Retinal fundus photograph, 45-degree field of view — 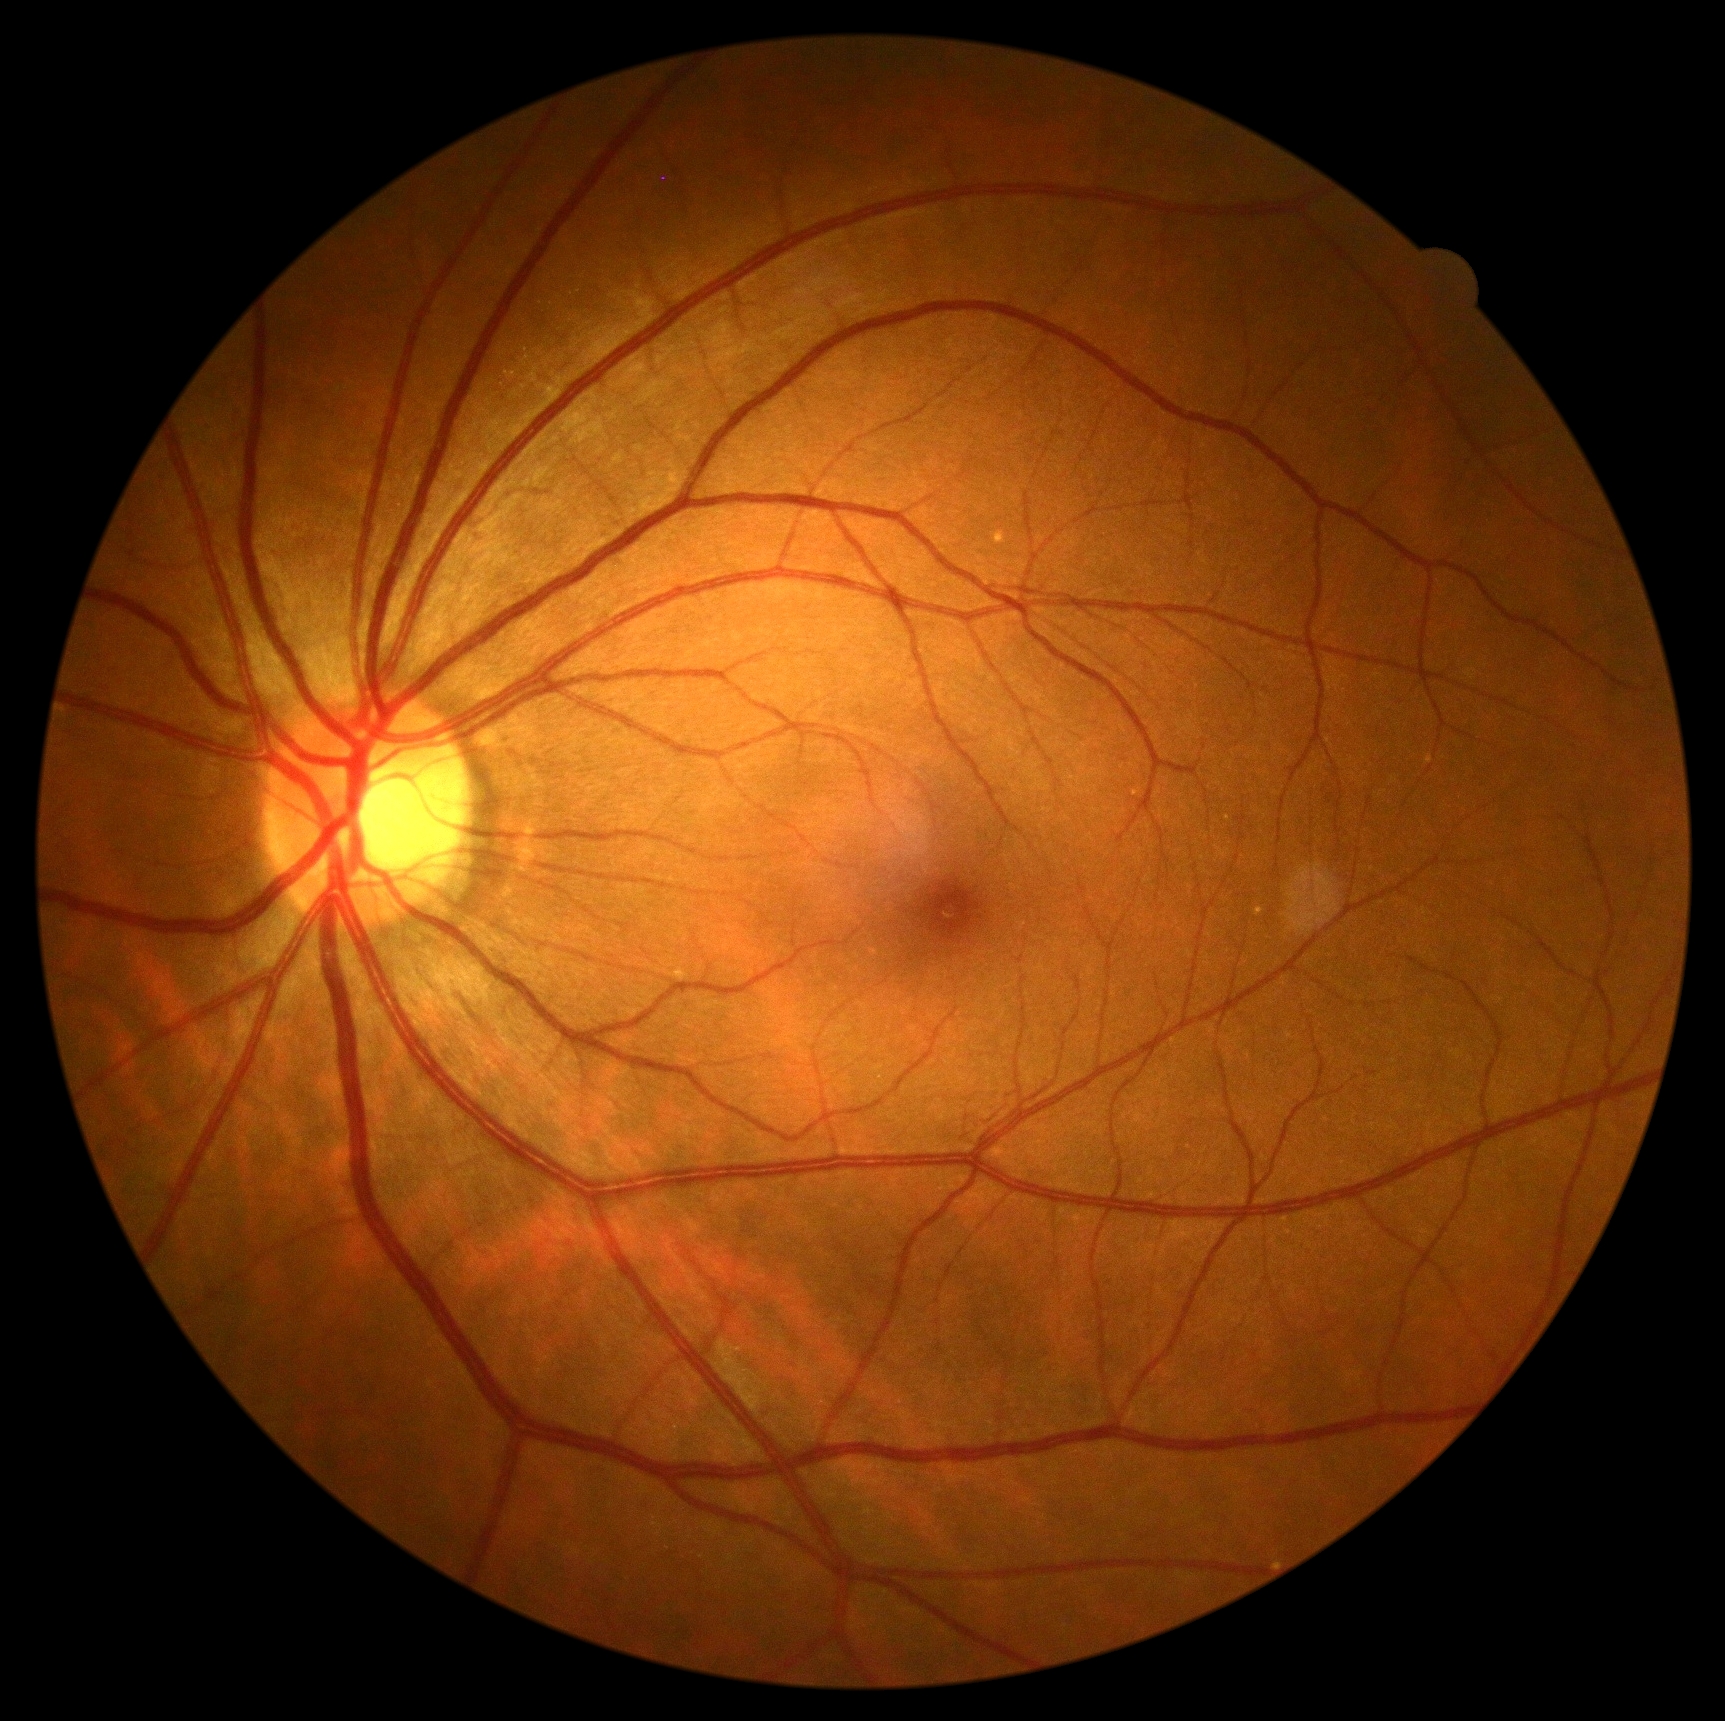

No signs of diabetic retinopathy.
Retinopathy grade is 0 (no apparent retinopathy).